Wide-field fundus photograph from neonatal ROP screening: 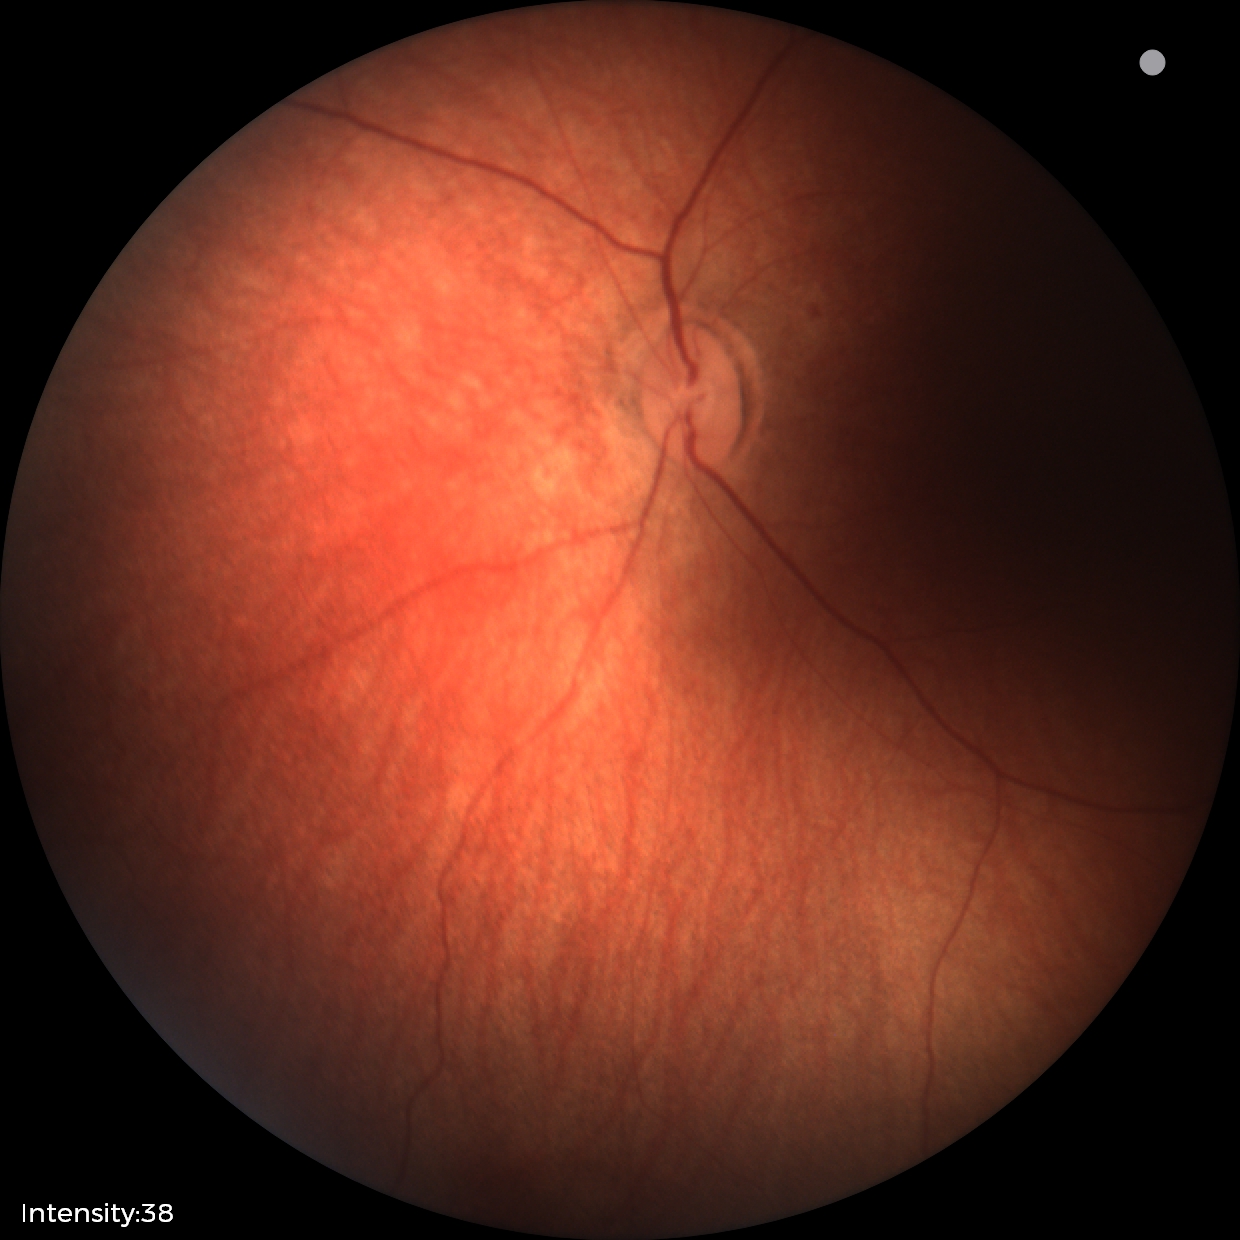 No retinal pathology identified on screening.